Acquired on the Clarity RetCam 3 · 640x480px · wide-field contact fundus photograph of an infant
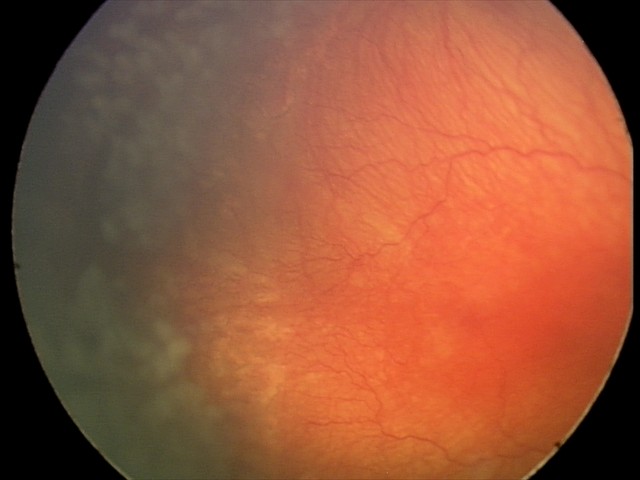 Plus disease was diagnosed. Diagnosis from this screening exam: aggressive retinopathy of prematurity.